Without pupil dilation; acquired with a NIDEK AFC-230; 45 degree fundus photograph; posterior pole color fundus photograph.
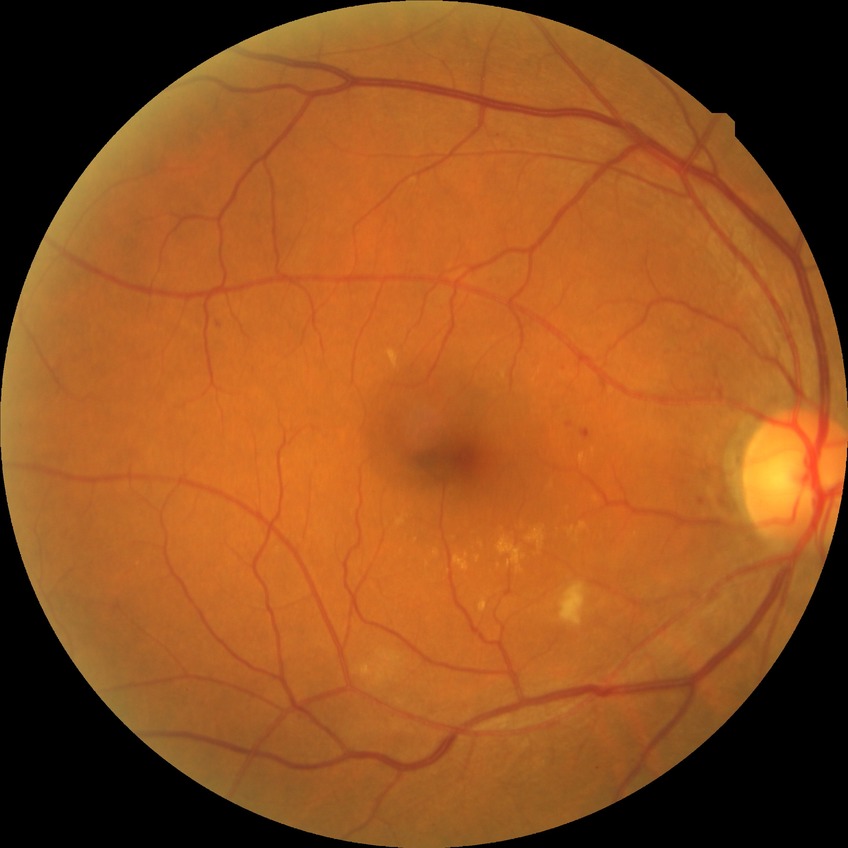 {
  "davis_grade": "PPDR"
}